45-degree field of view.
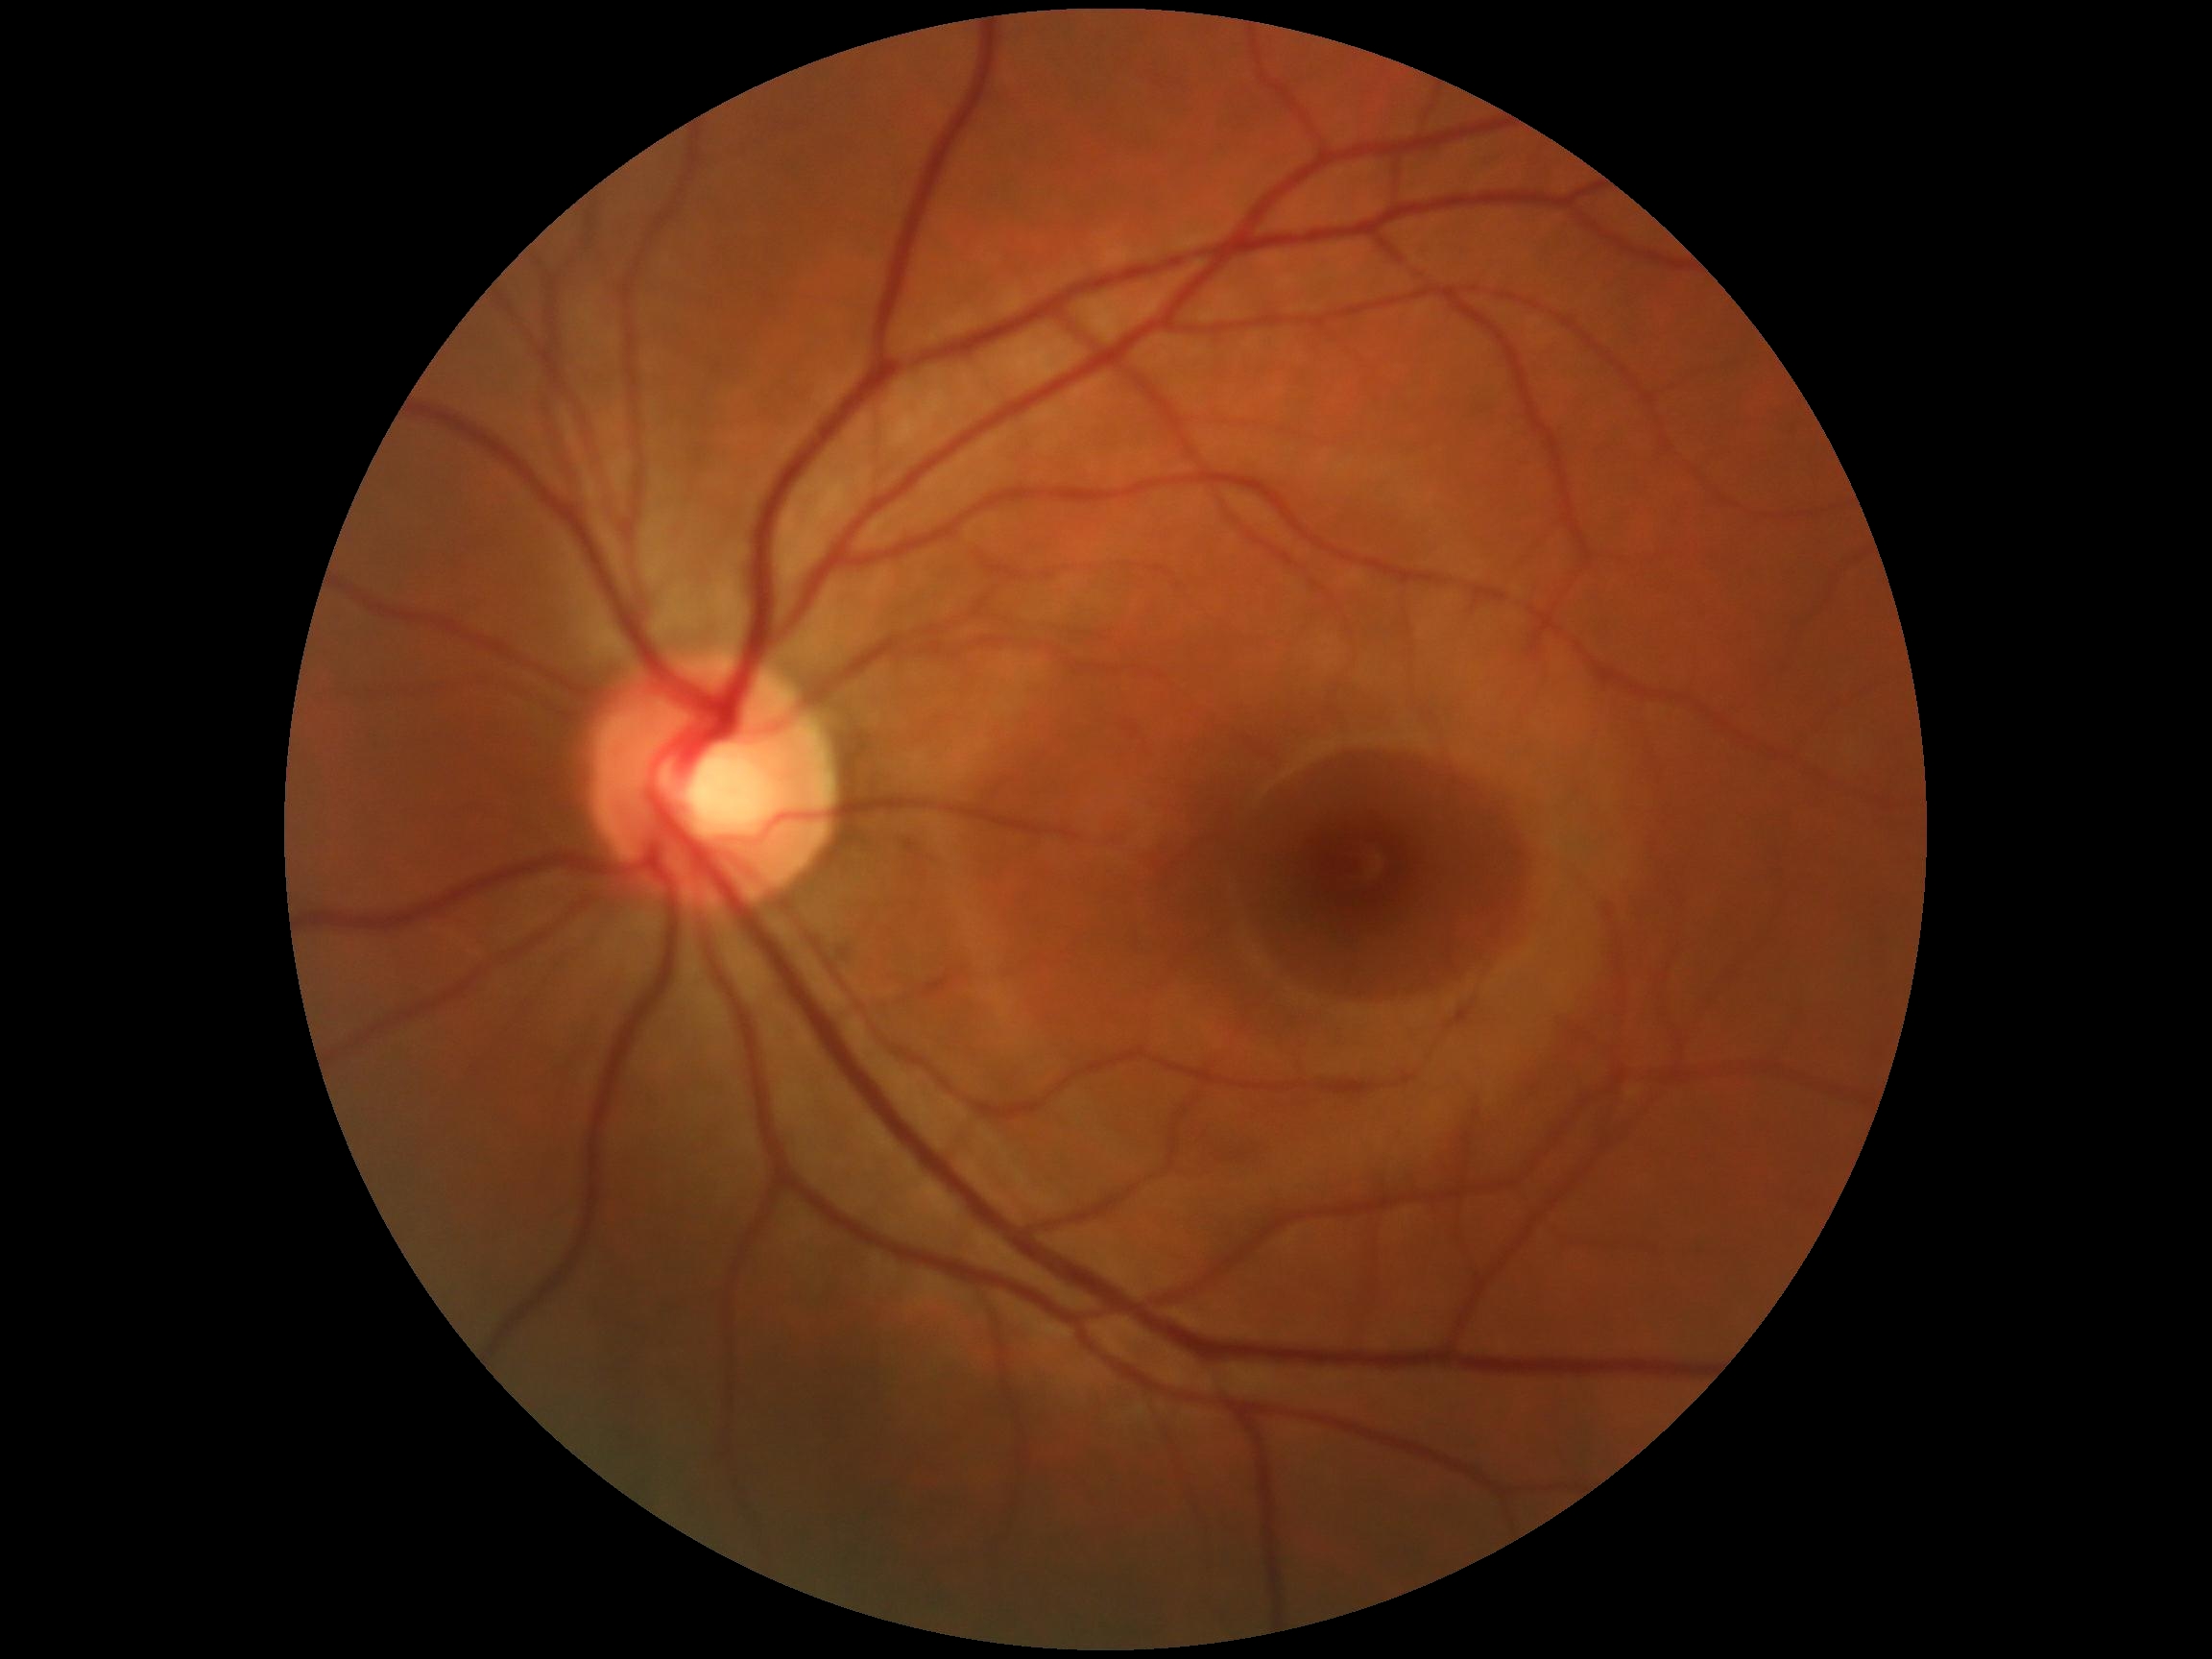

Retinopathy: no apparent diabetic retinopathy (grade 0) — no visible signs of diabetic retinopathy.